Retinal fundus photograph; 848 x 848 pixels; no pharmacologic dilation; NIDEK AFC-230; graded on the modified Davis scale
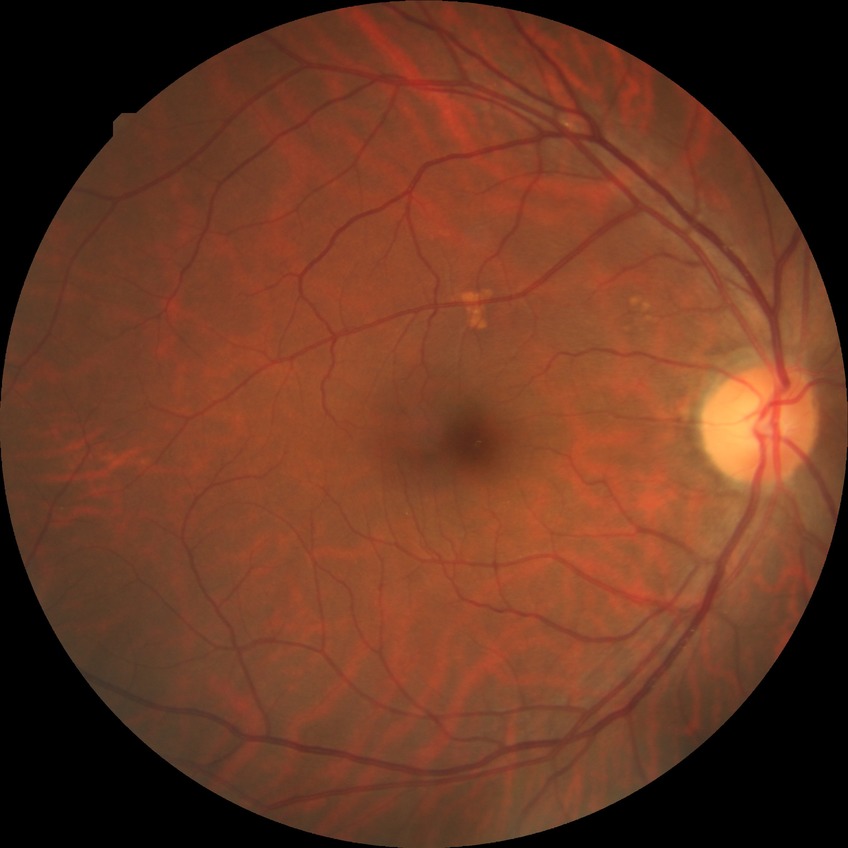 Davis grading: no diabetic retinopathy.